Wide-field fundus photograph from neonatal ROP screening · image size 1240x1240.
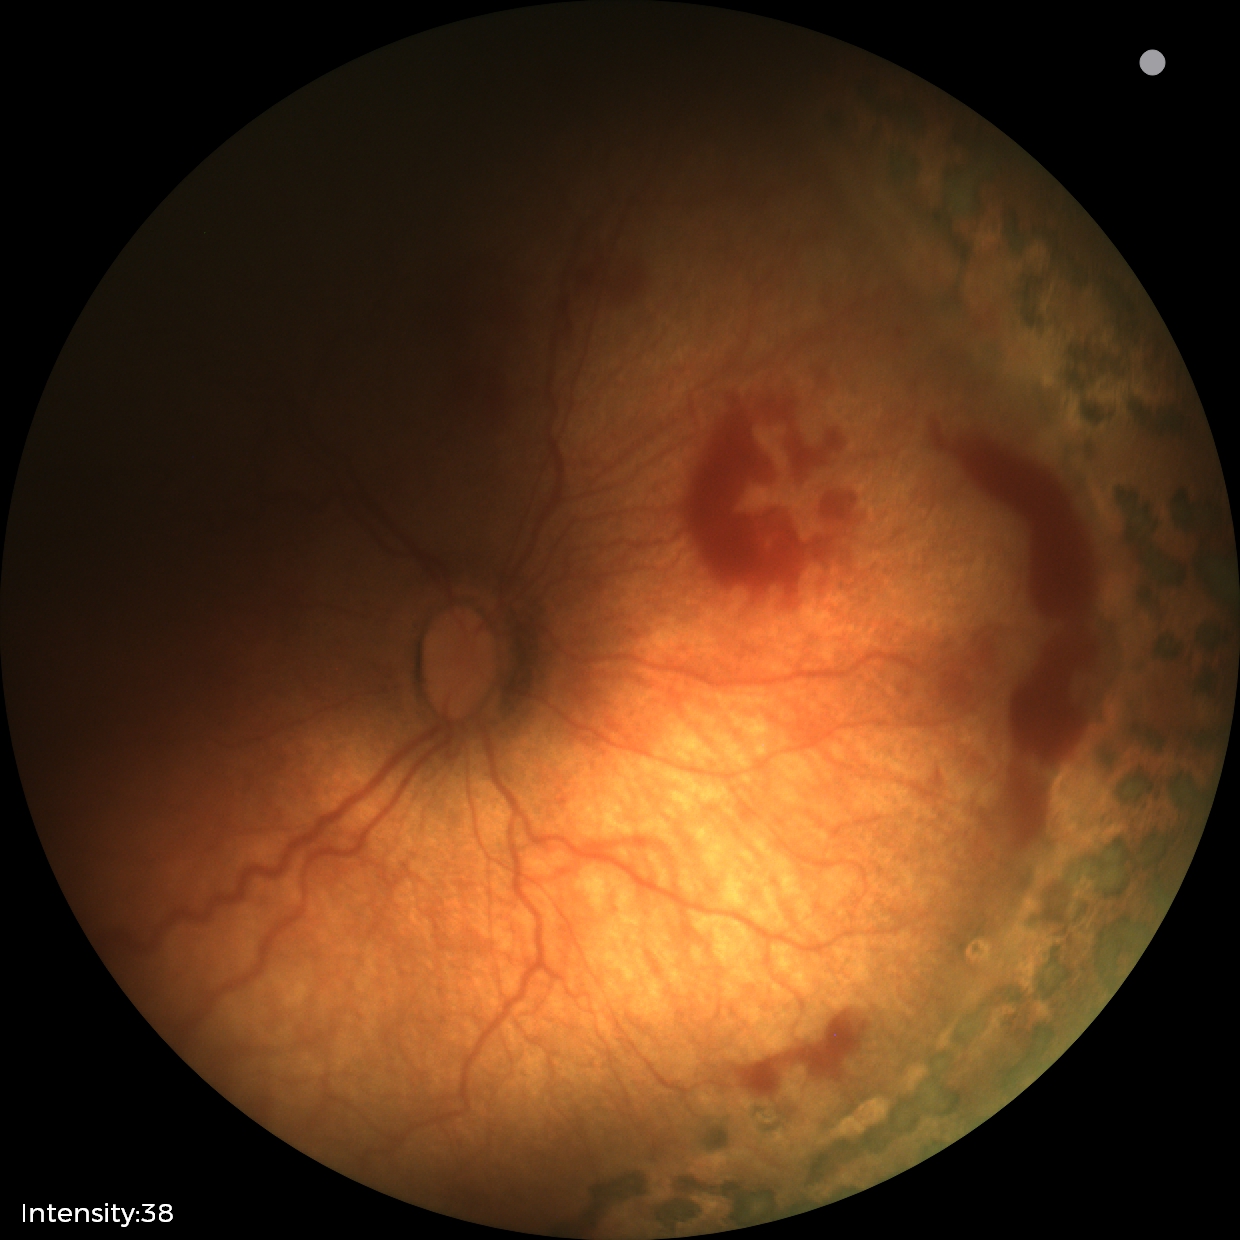

Assessment: status post retinopathy of prematurity.